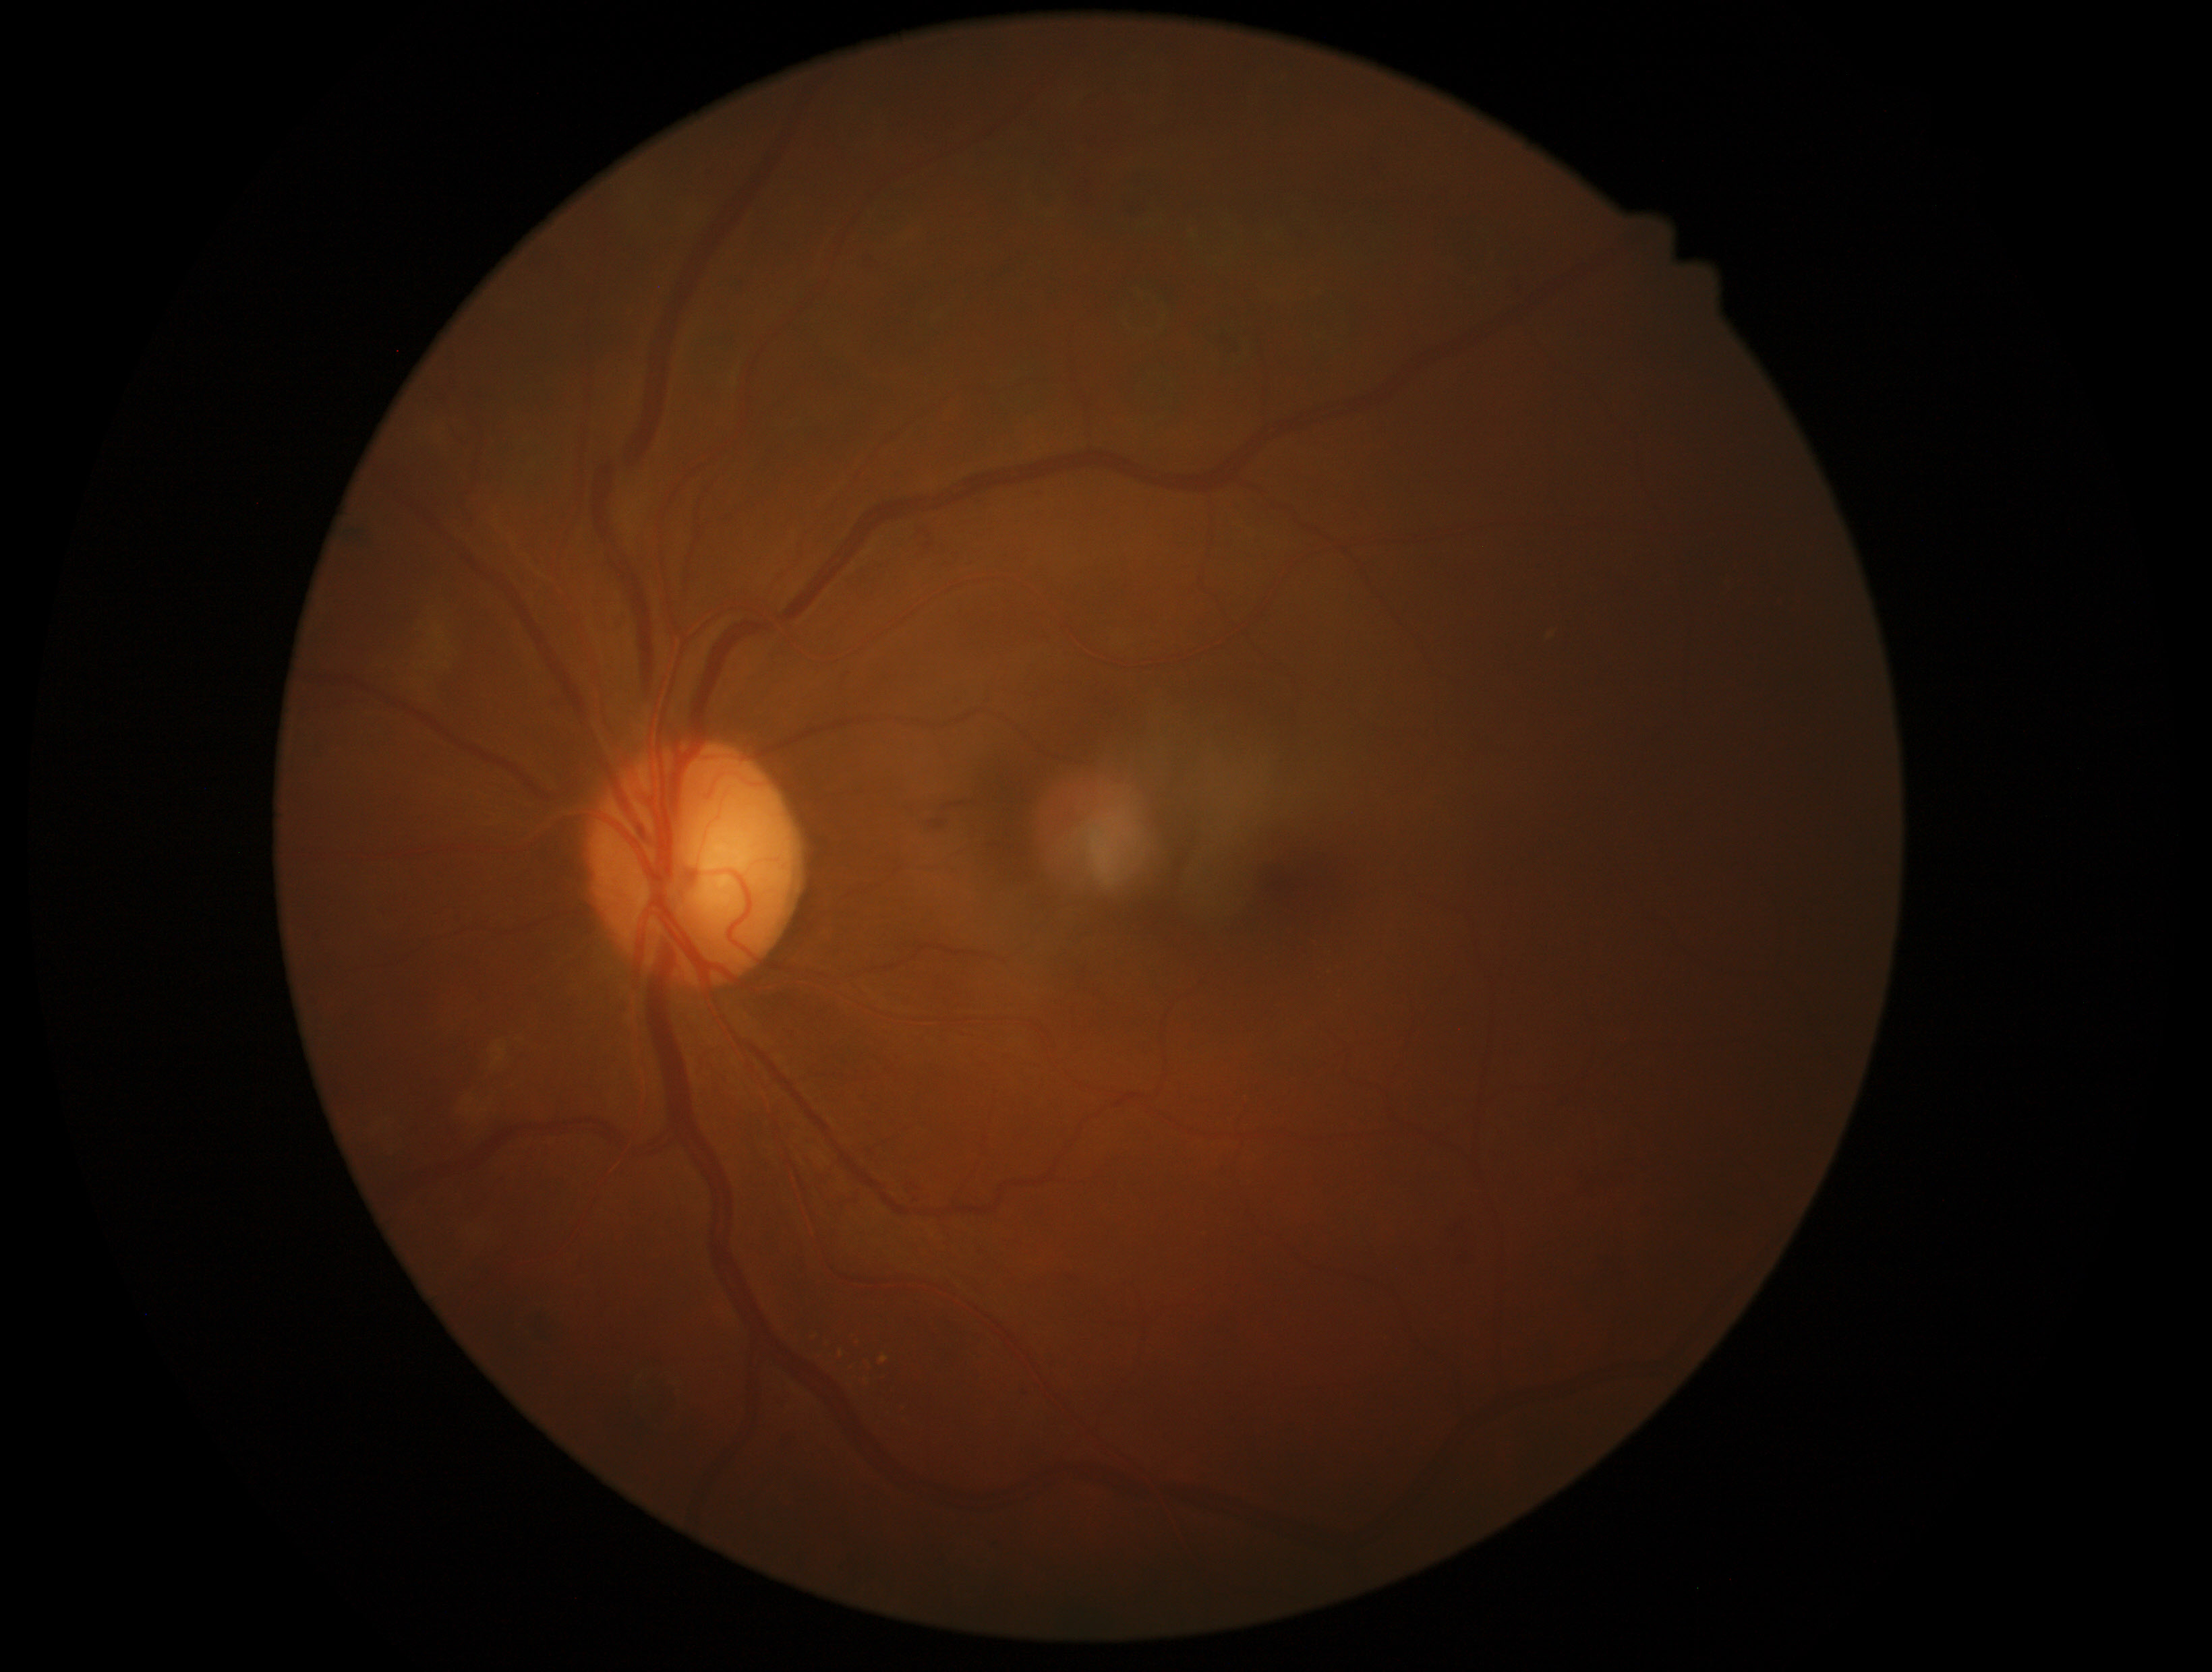
diabetic retinopathy grade: 2 (moderate NPDR).